Posterior pole photograph · FOV: 45 degrees: 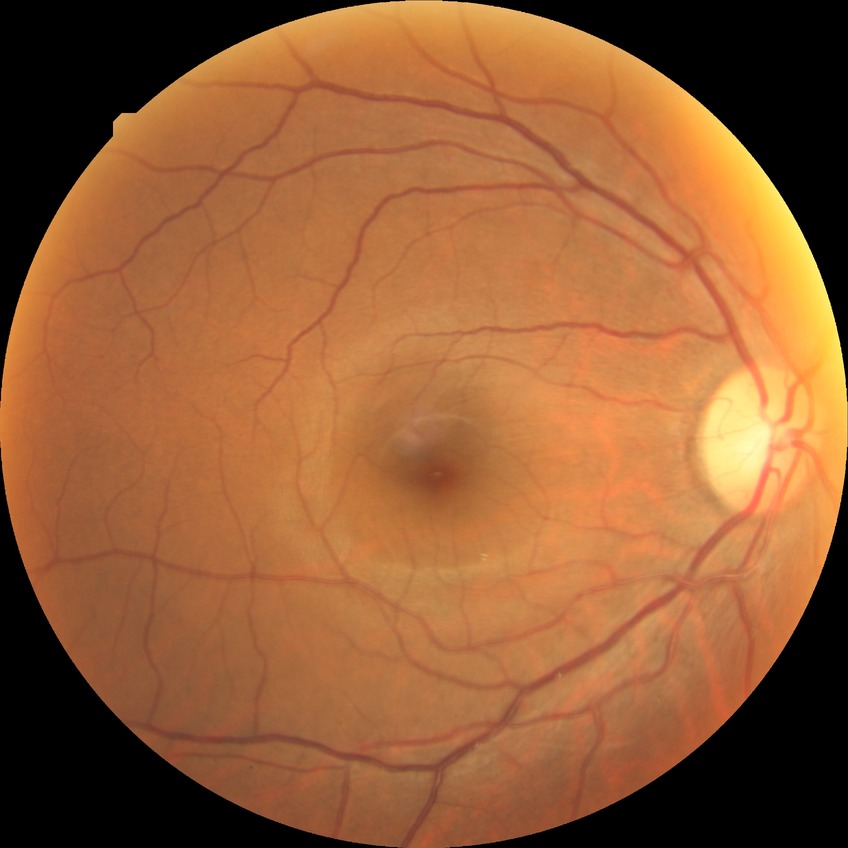 Assessment:
- modified Davis classification: no diabetic retinopathy